Wide-field fundus photograph from neonatal ROP screening · 640x480: 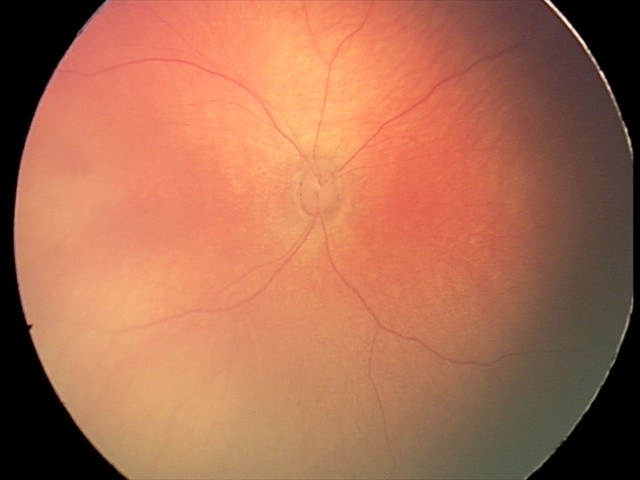
Screening examination consistent with retinal hemorrhages.